45° field of view, color fundus photograph
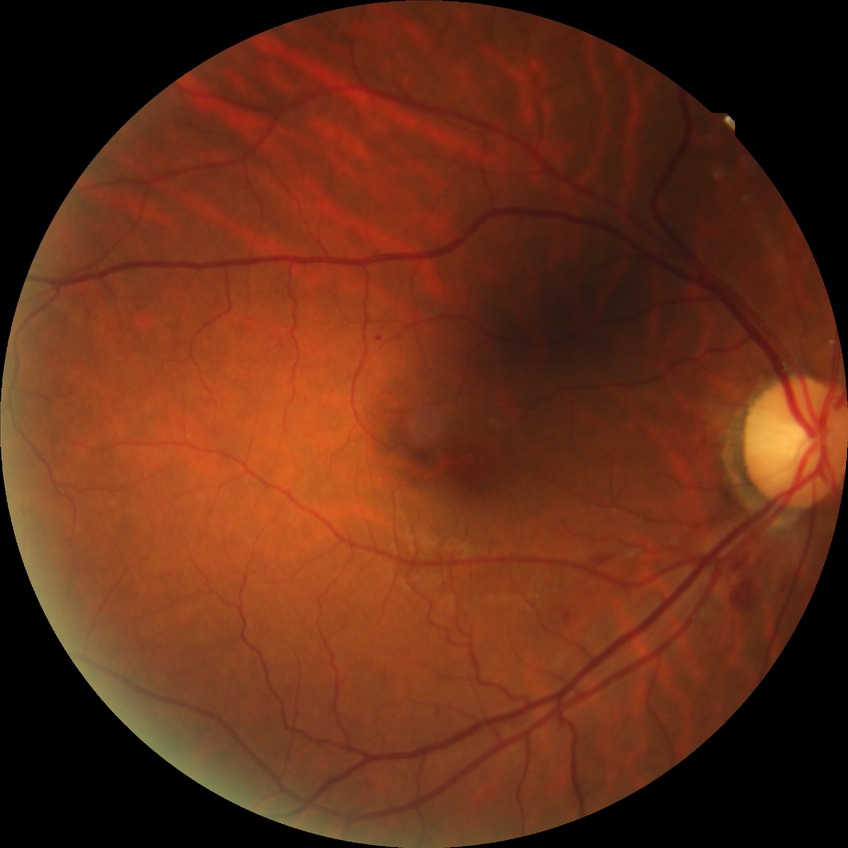

Findings:
- diabetic retinopathy stage: simple diabetic retinopathy